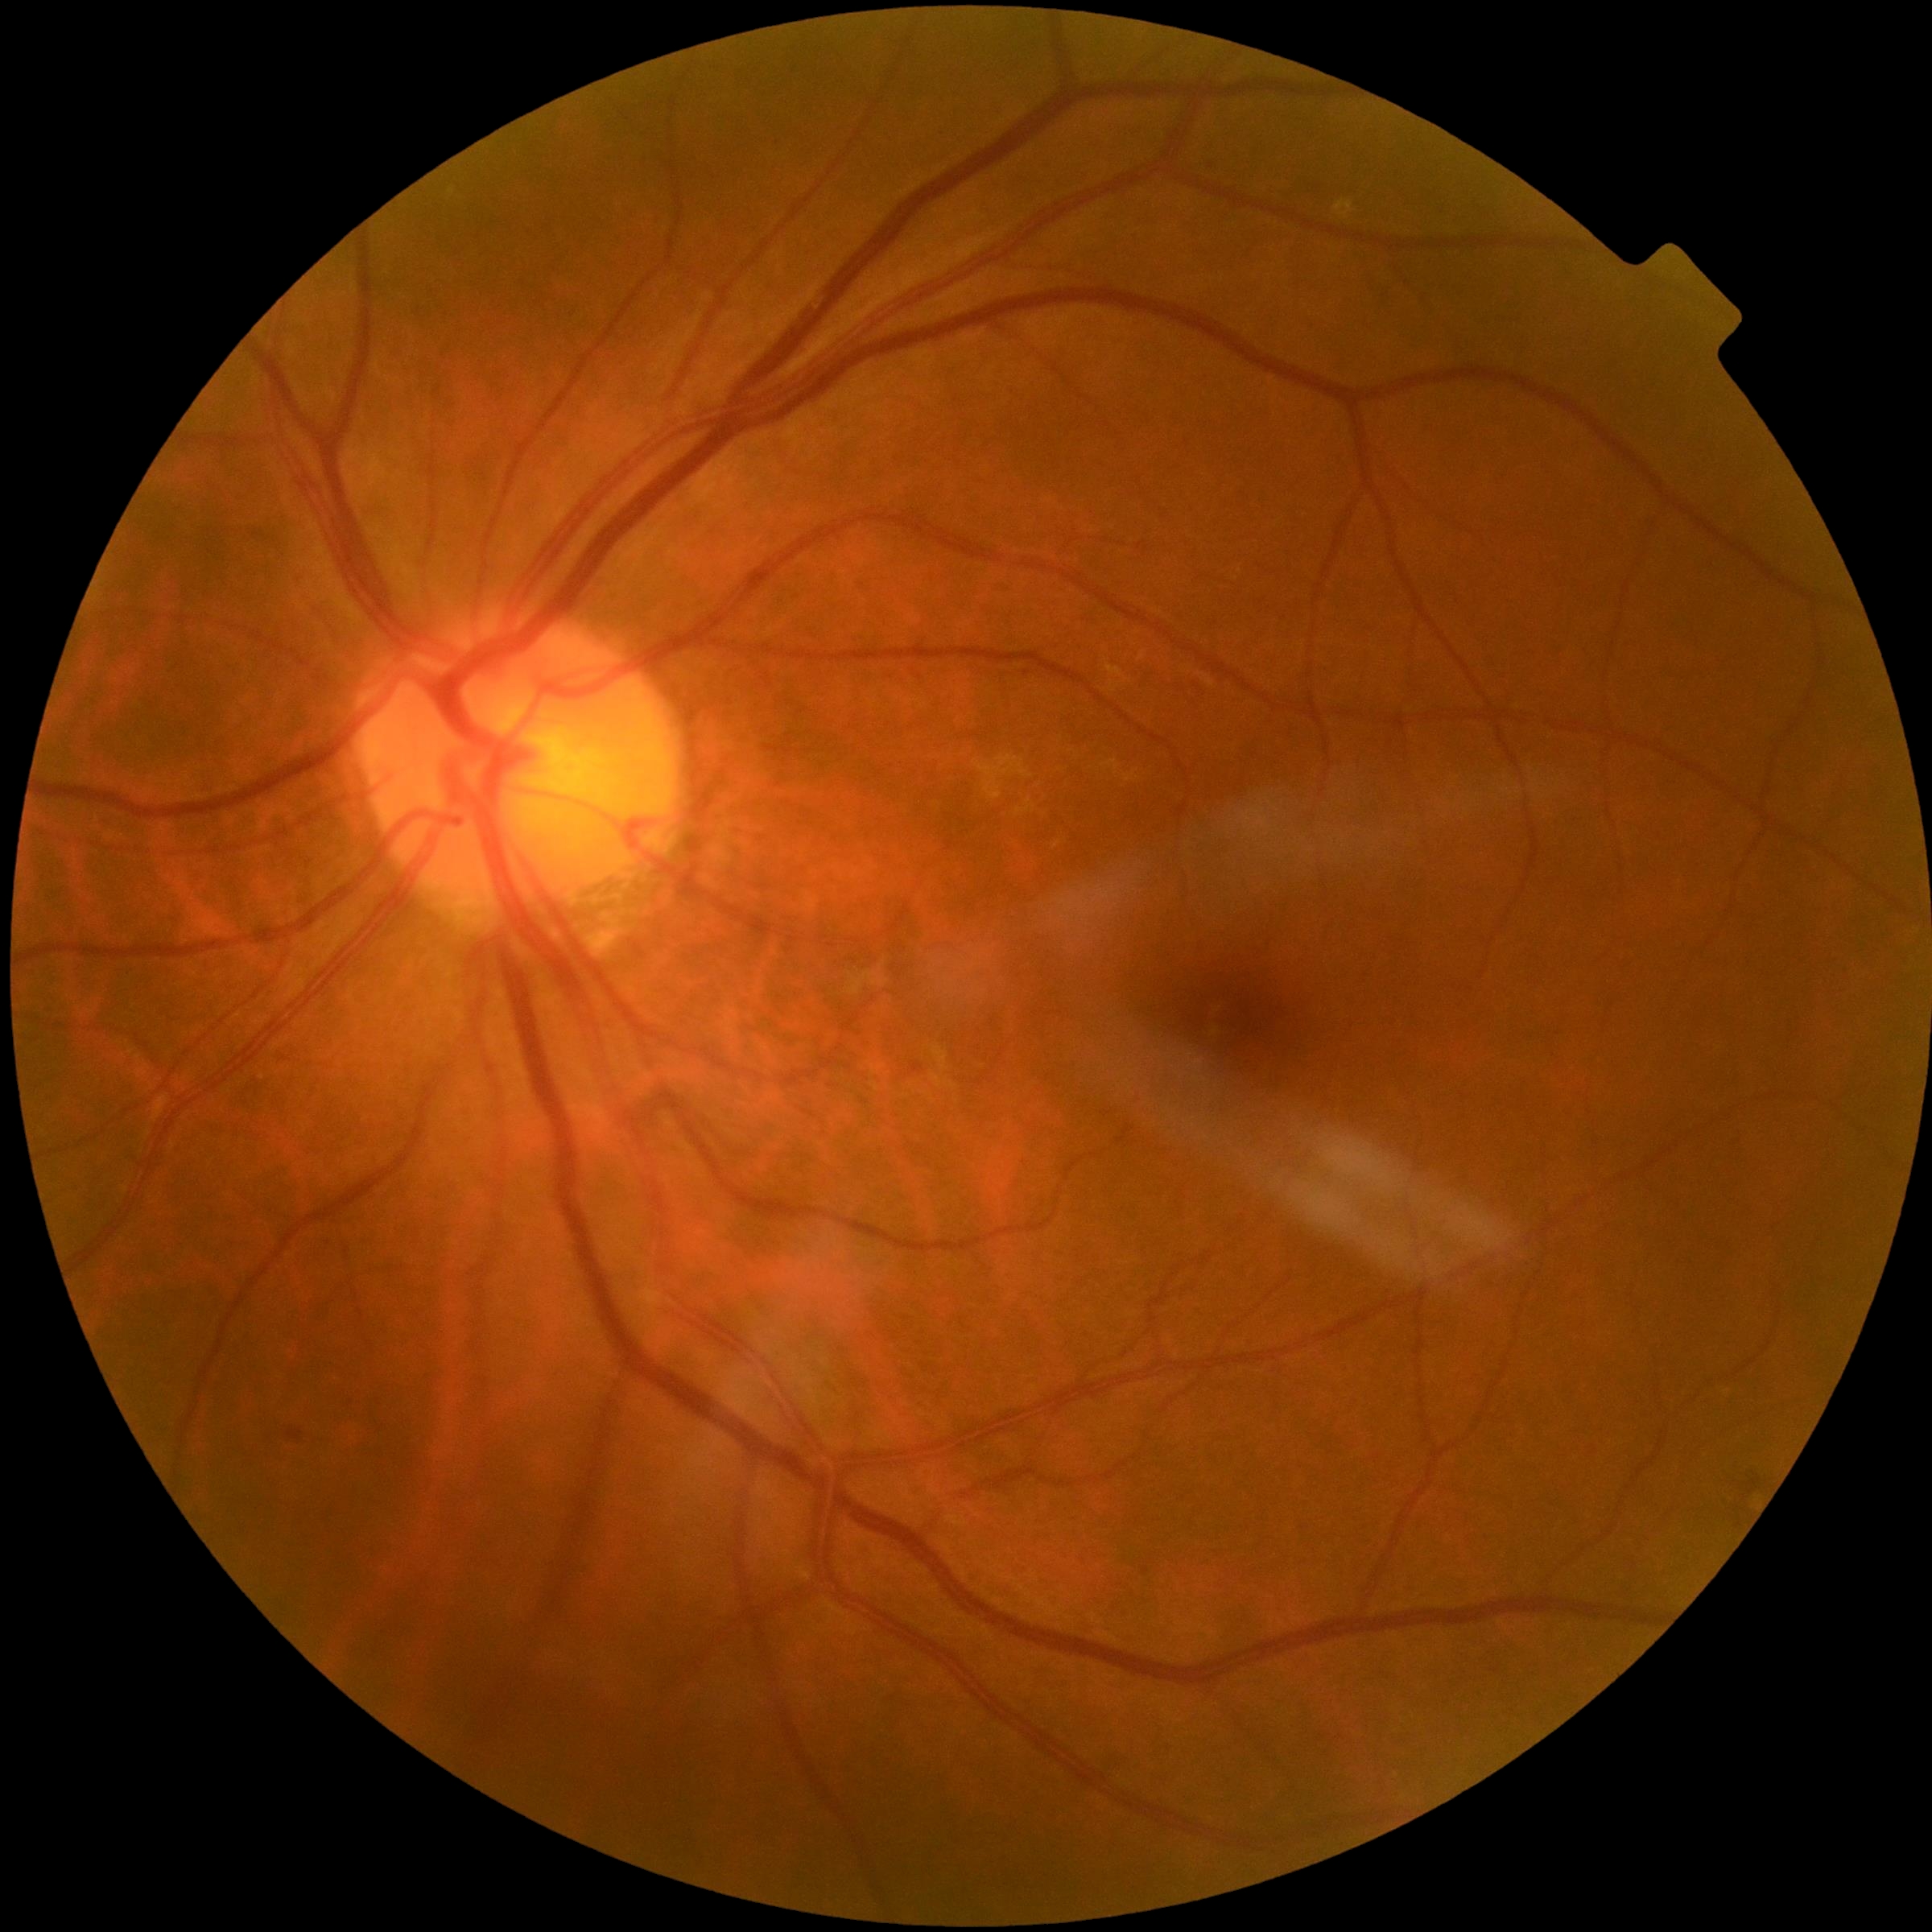
diabetic retinopathy (DR): 0/4